FOV: 45 degrees: 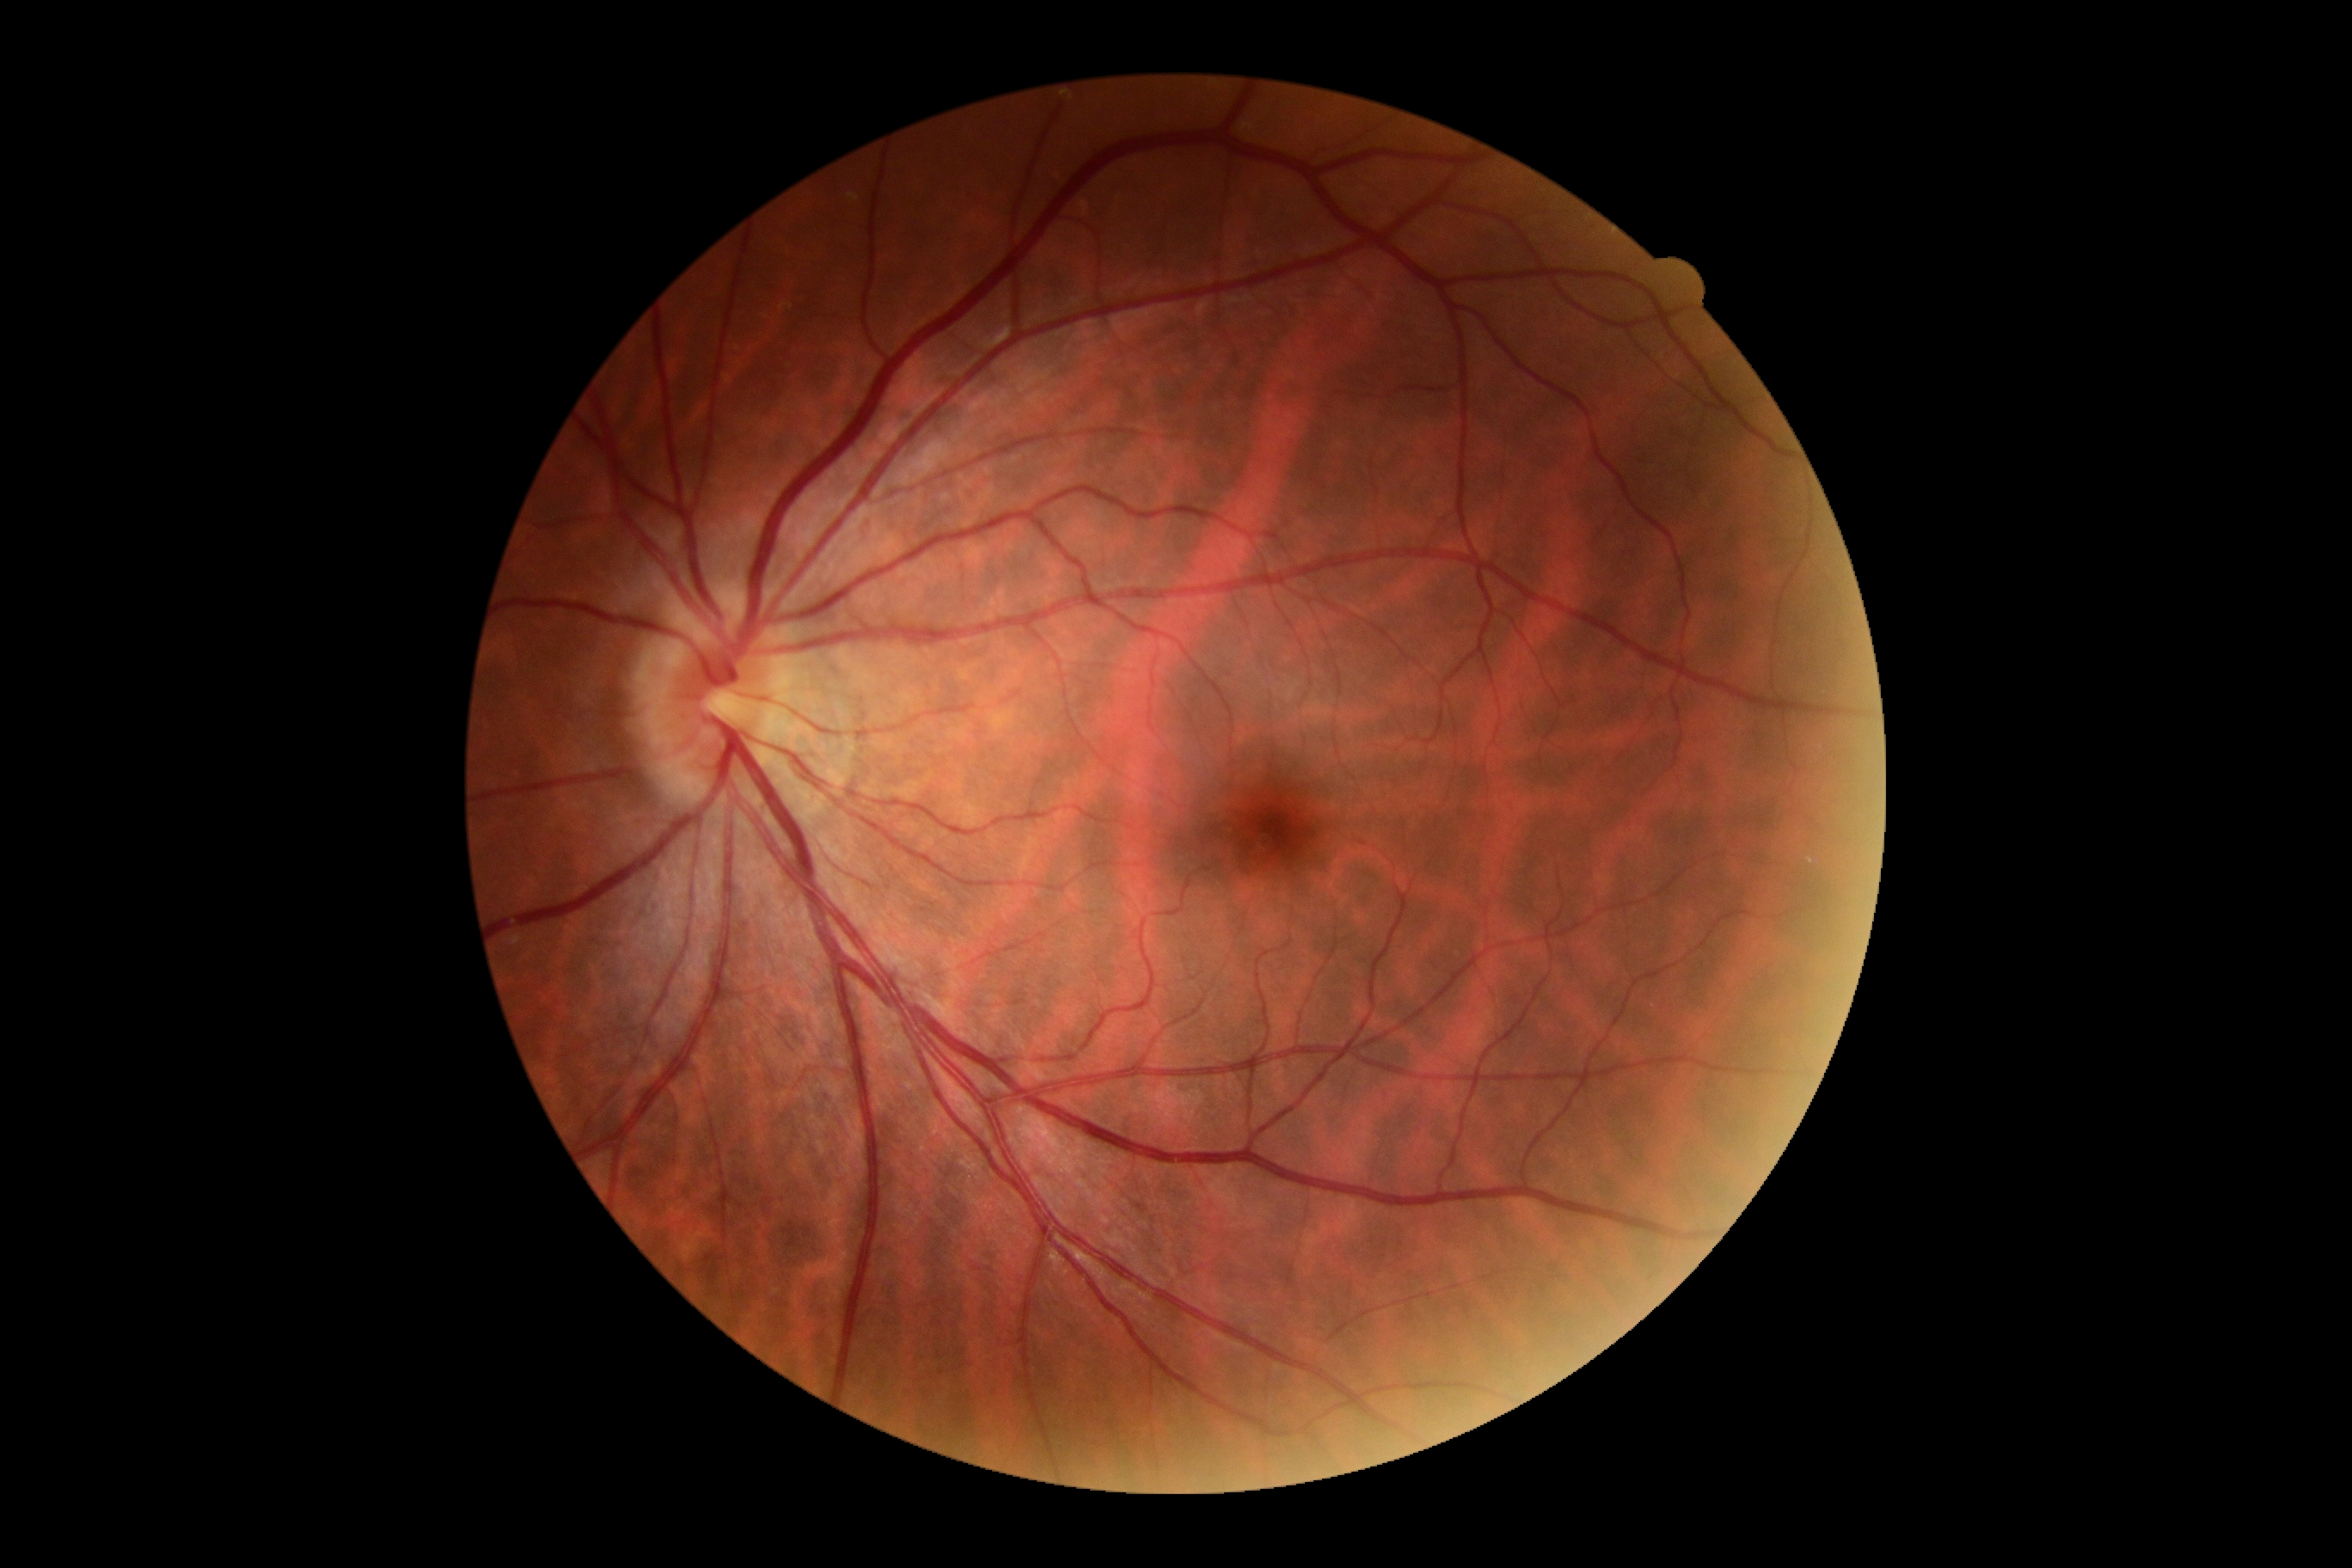

No signs of diabetic retinopathy.
Diabetic retinopathy grade: 0 (no apparent retinopathy) — no visible signs of diabetic retinopathy.